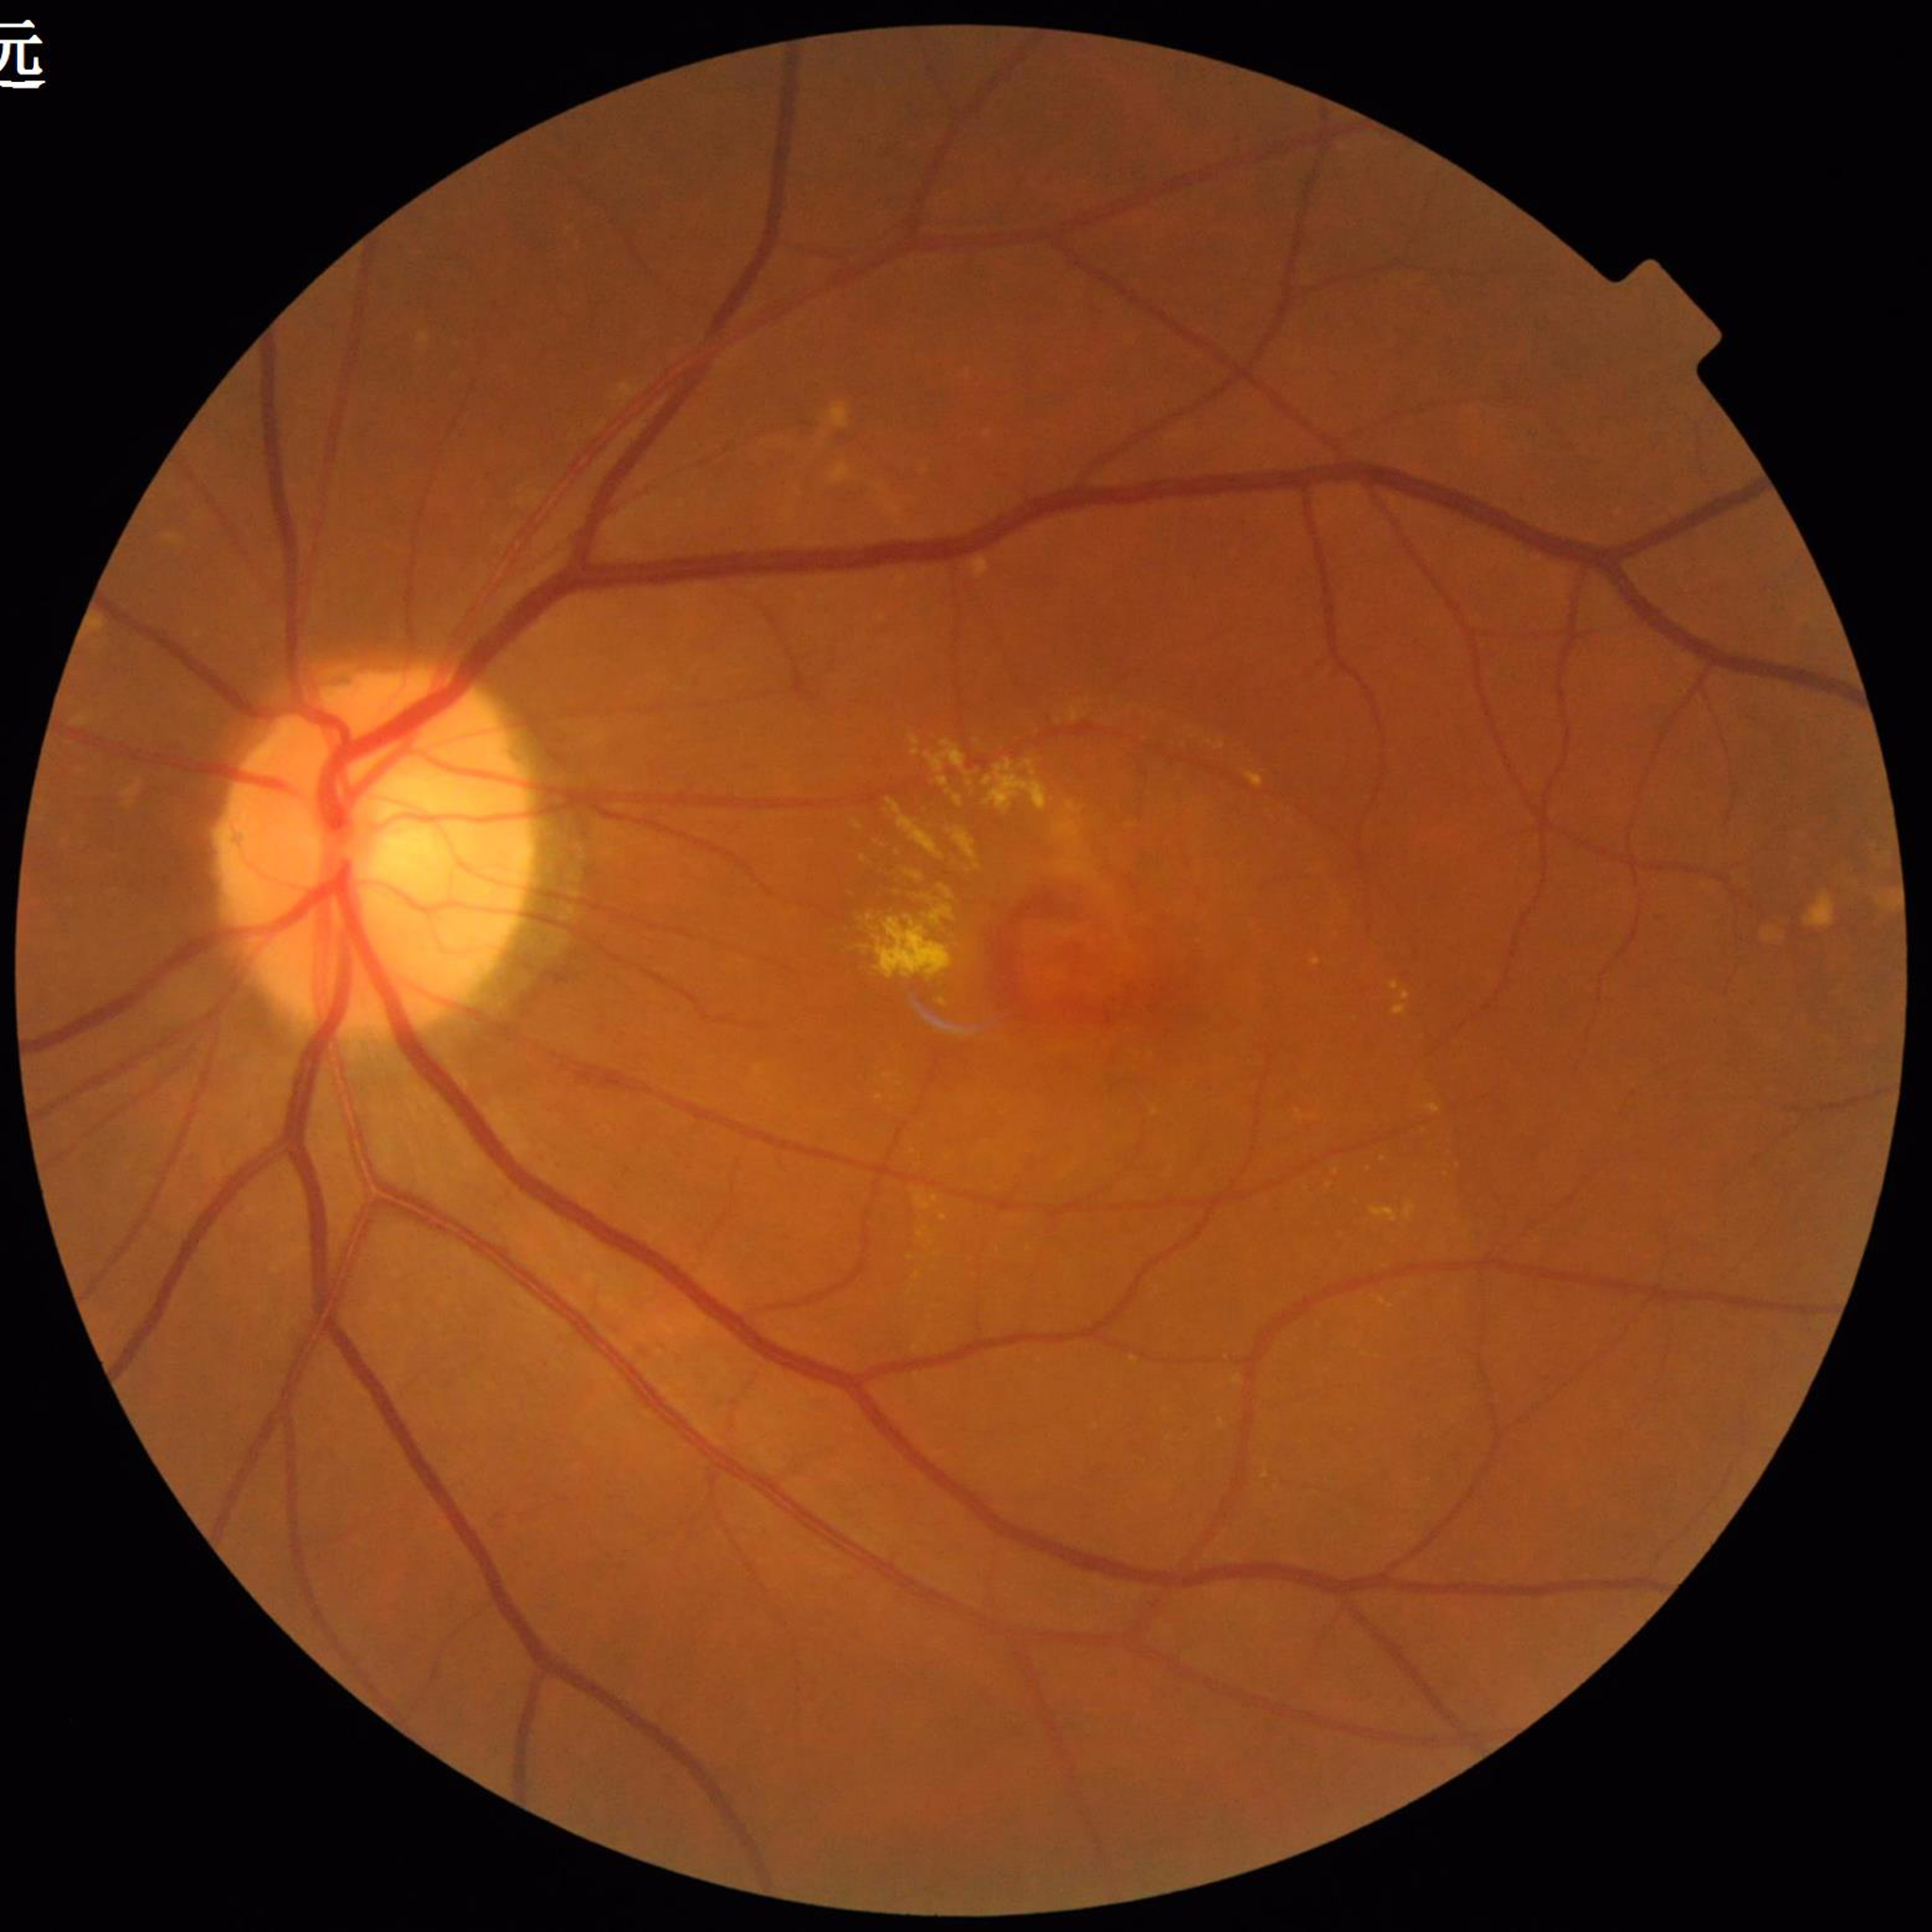
Condition: AMD